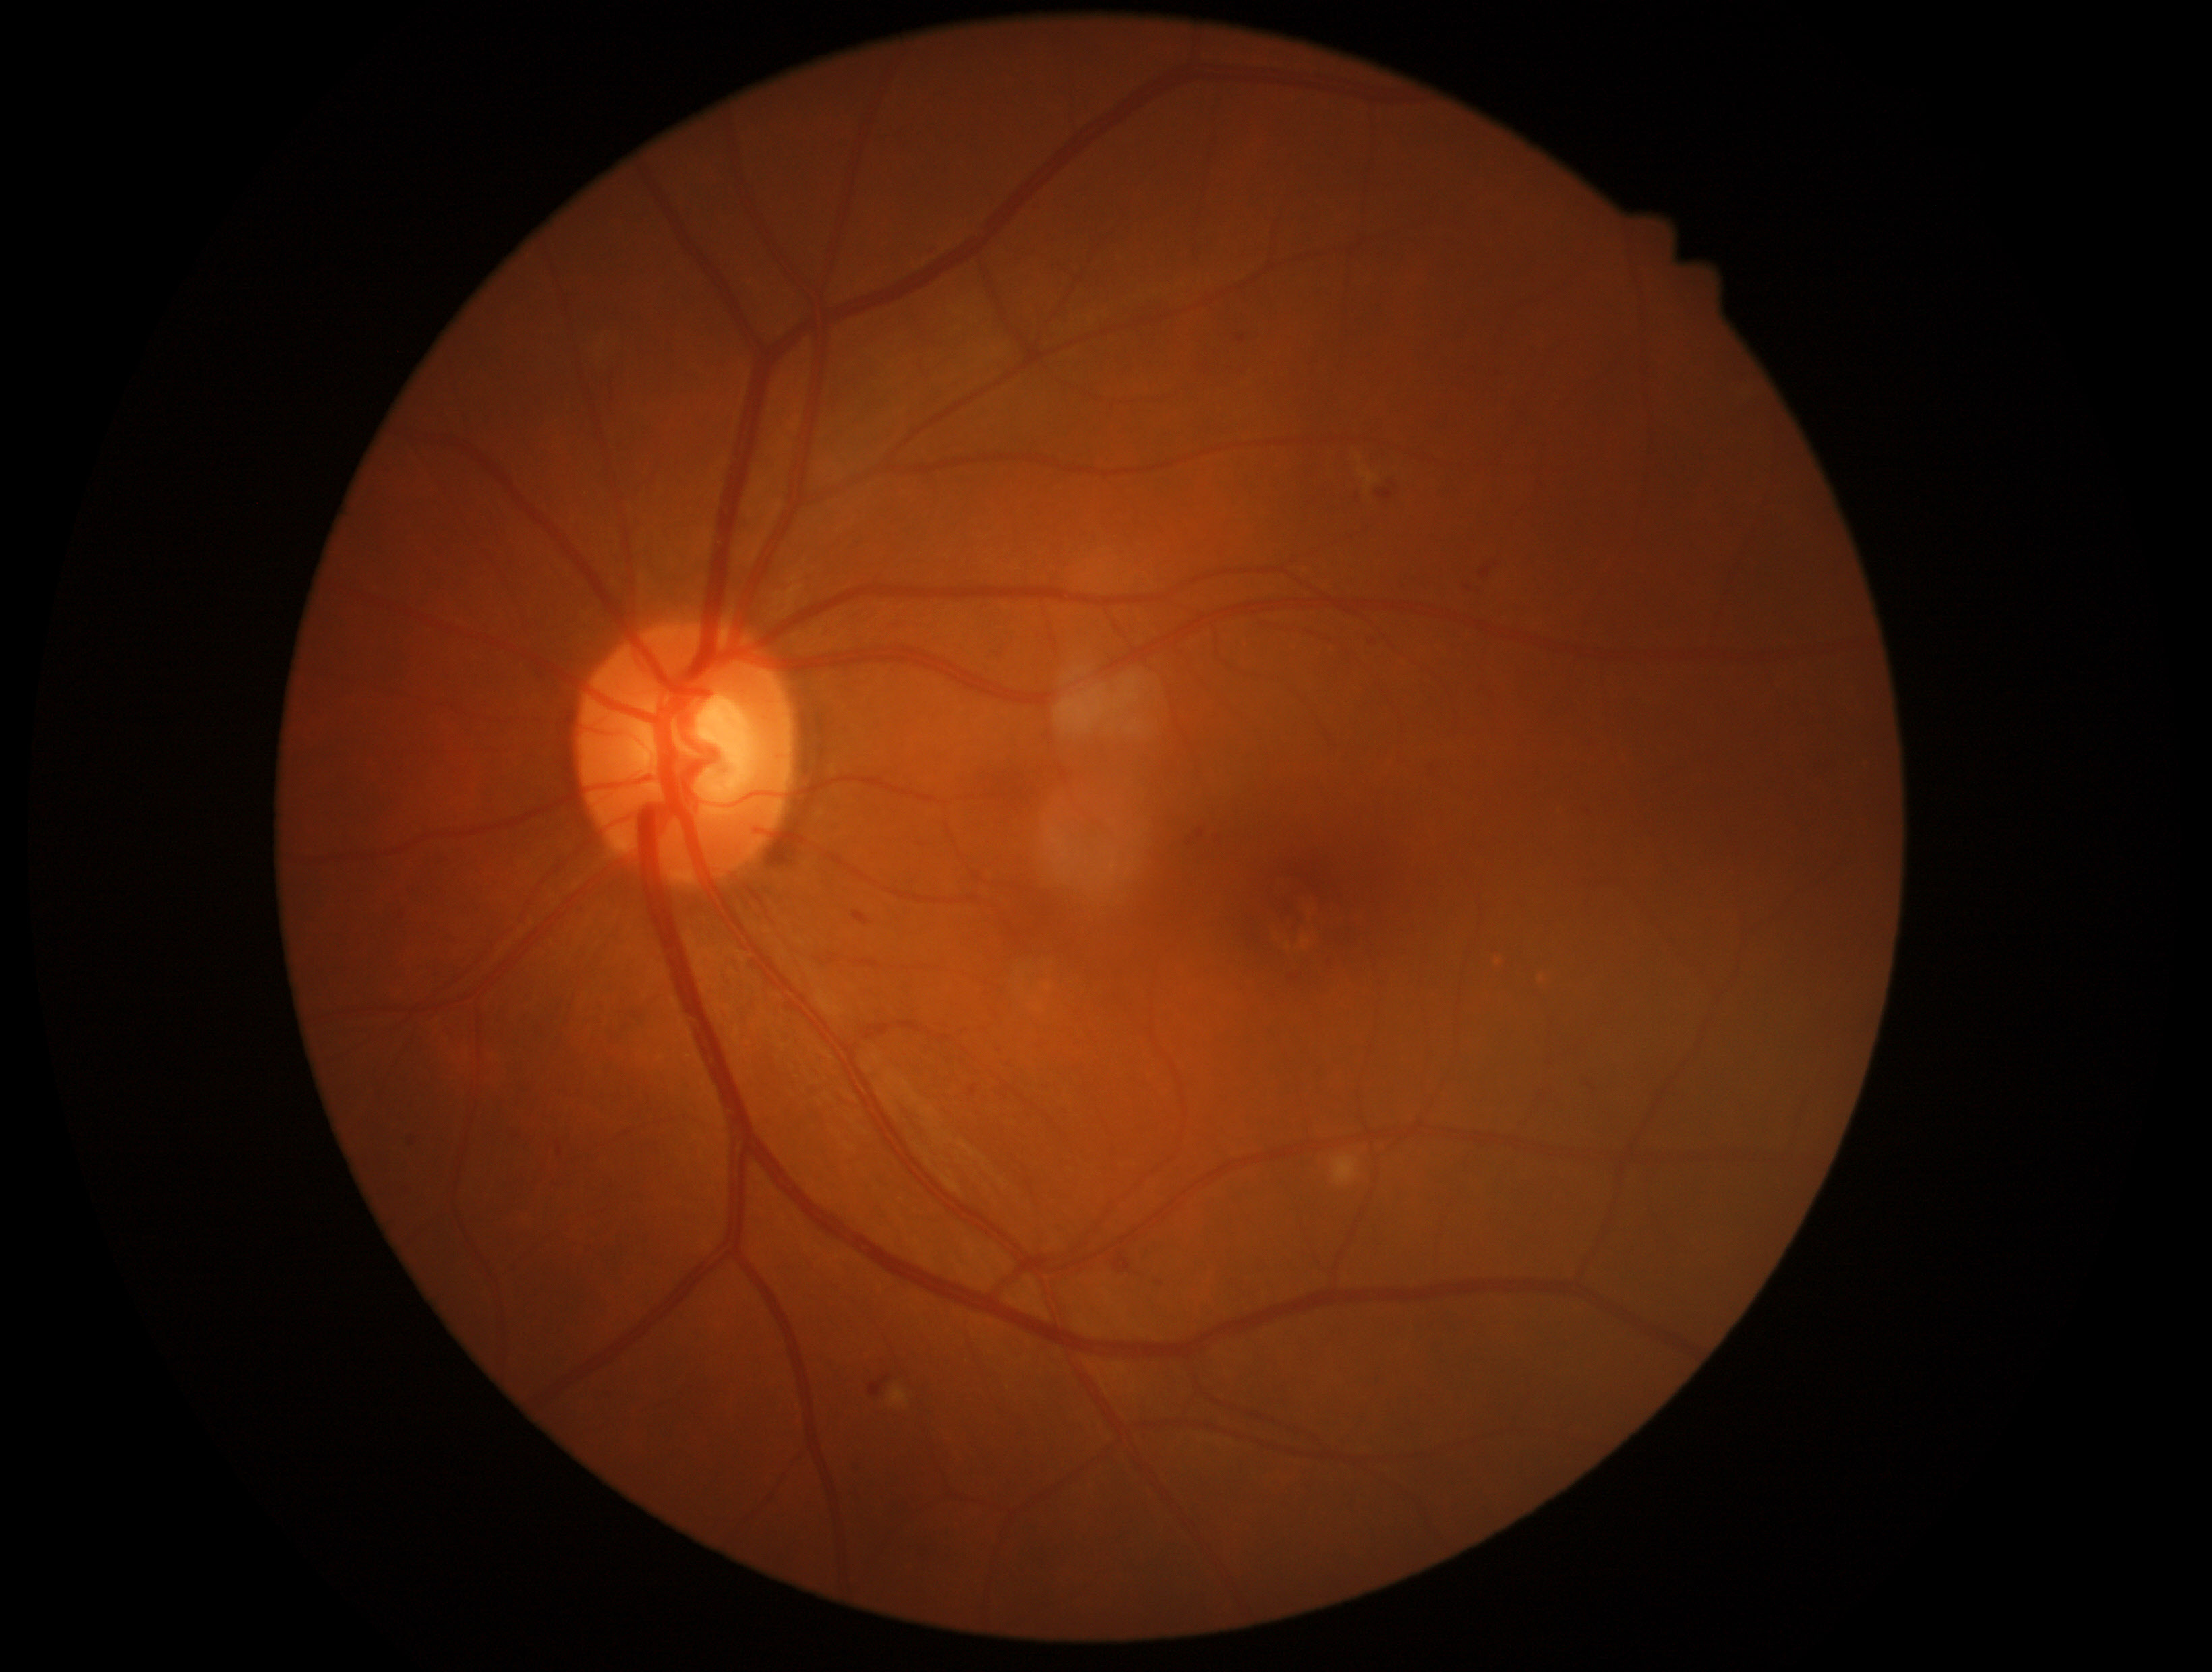 DR stage: grade 2 (moderate NPDR) — more than just microaneurysms but less than severe NPDR.